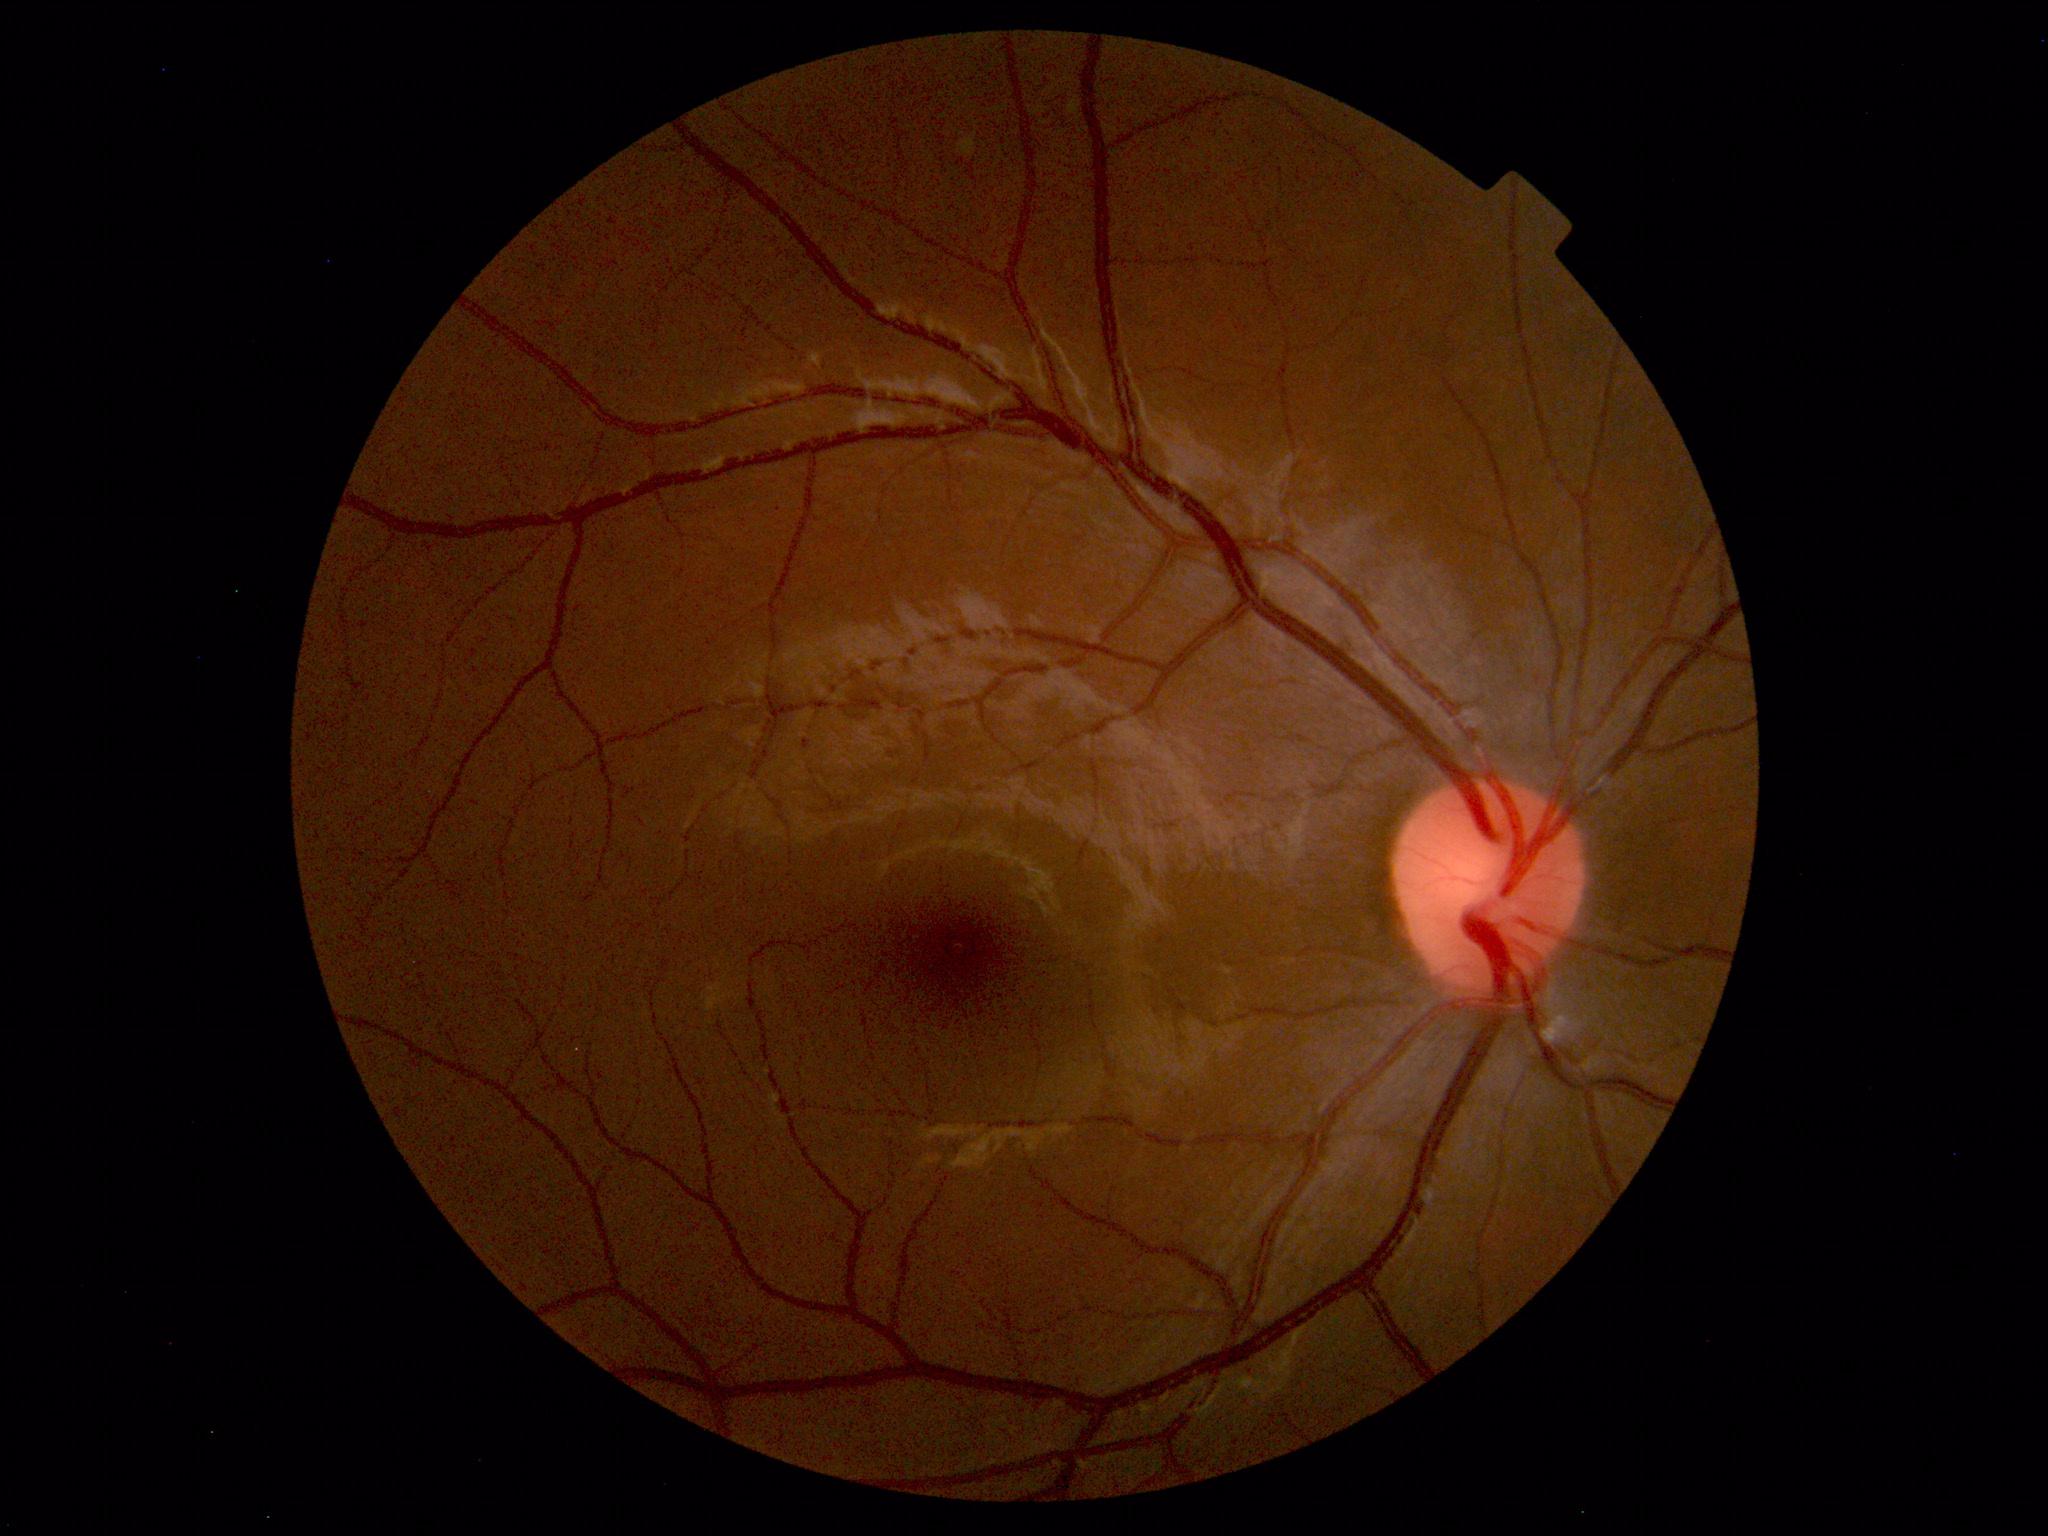

Findings: none. Normal fundus.